FOV: 45 degrees
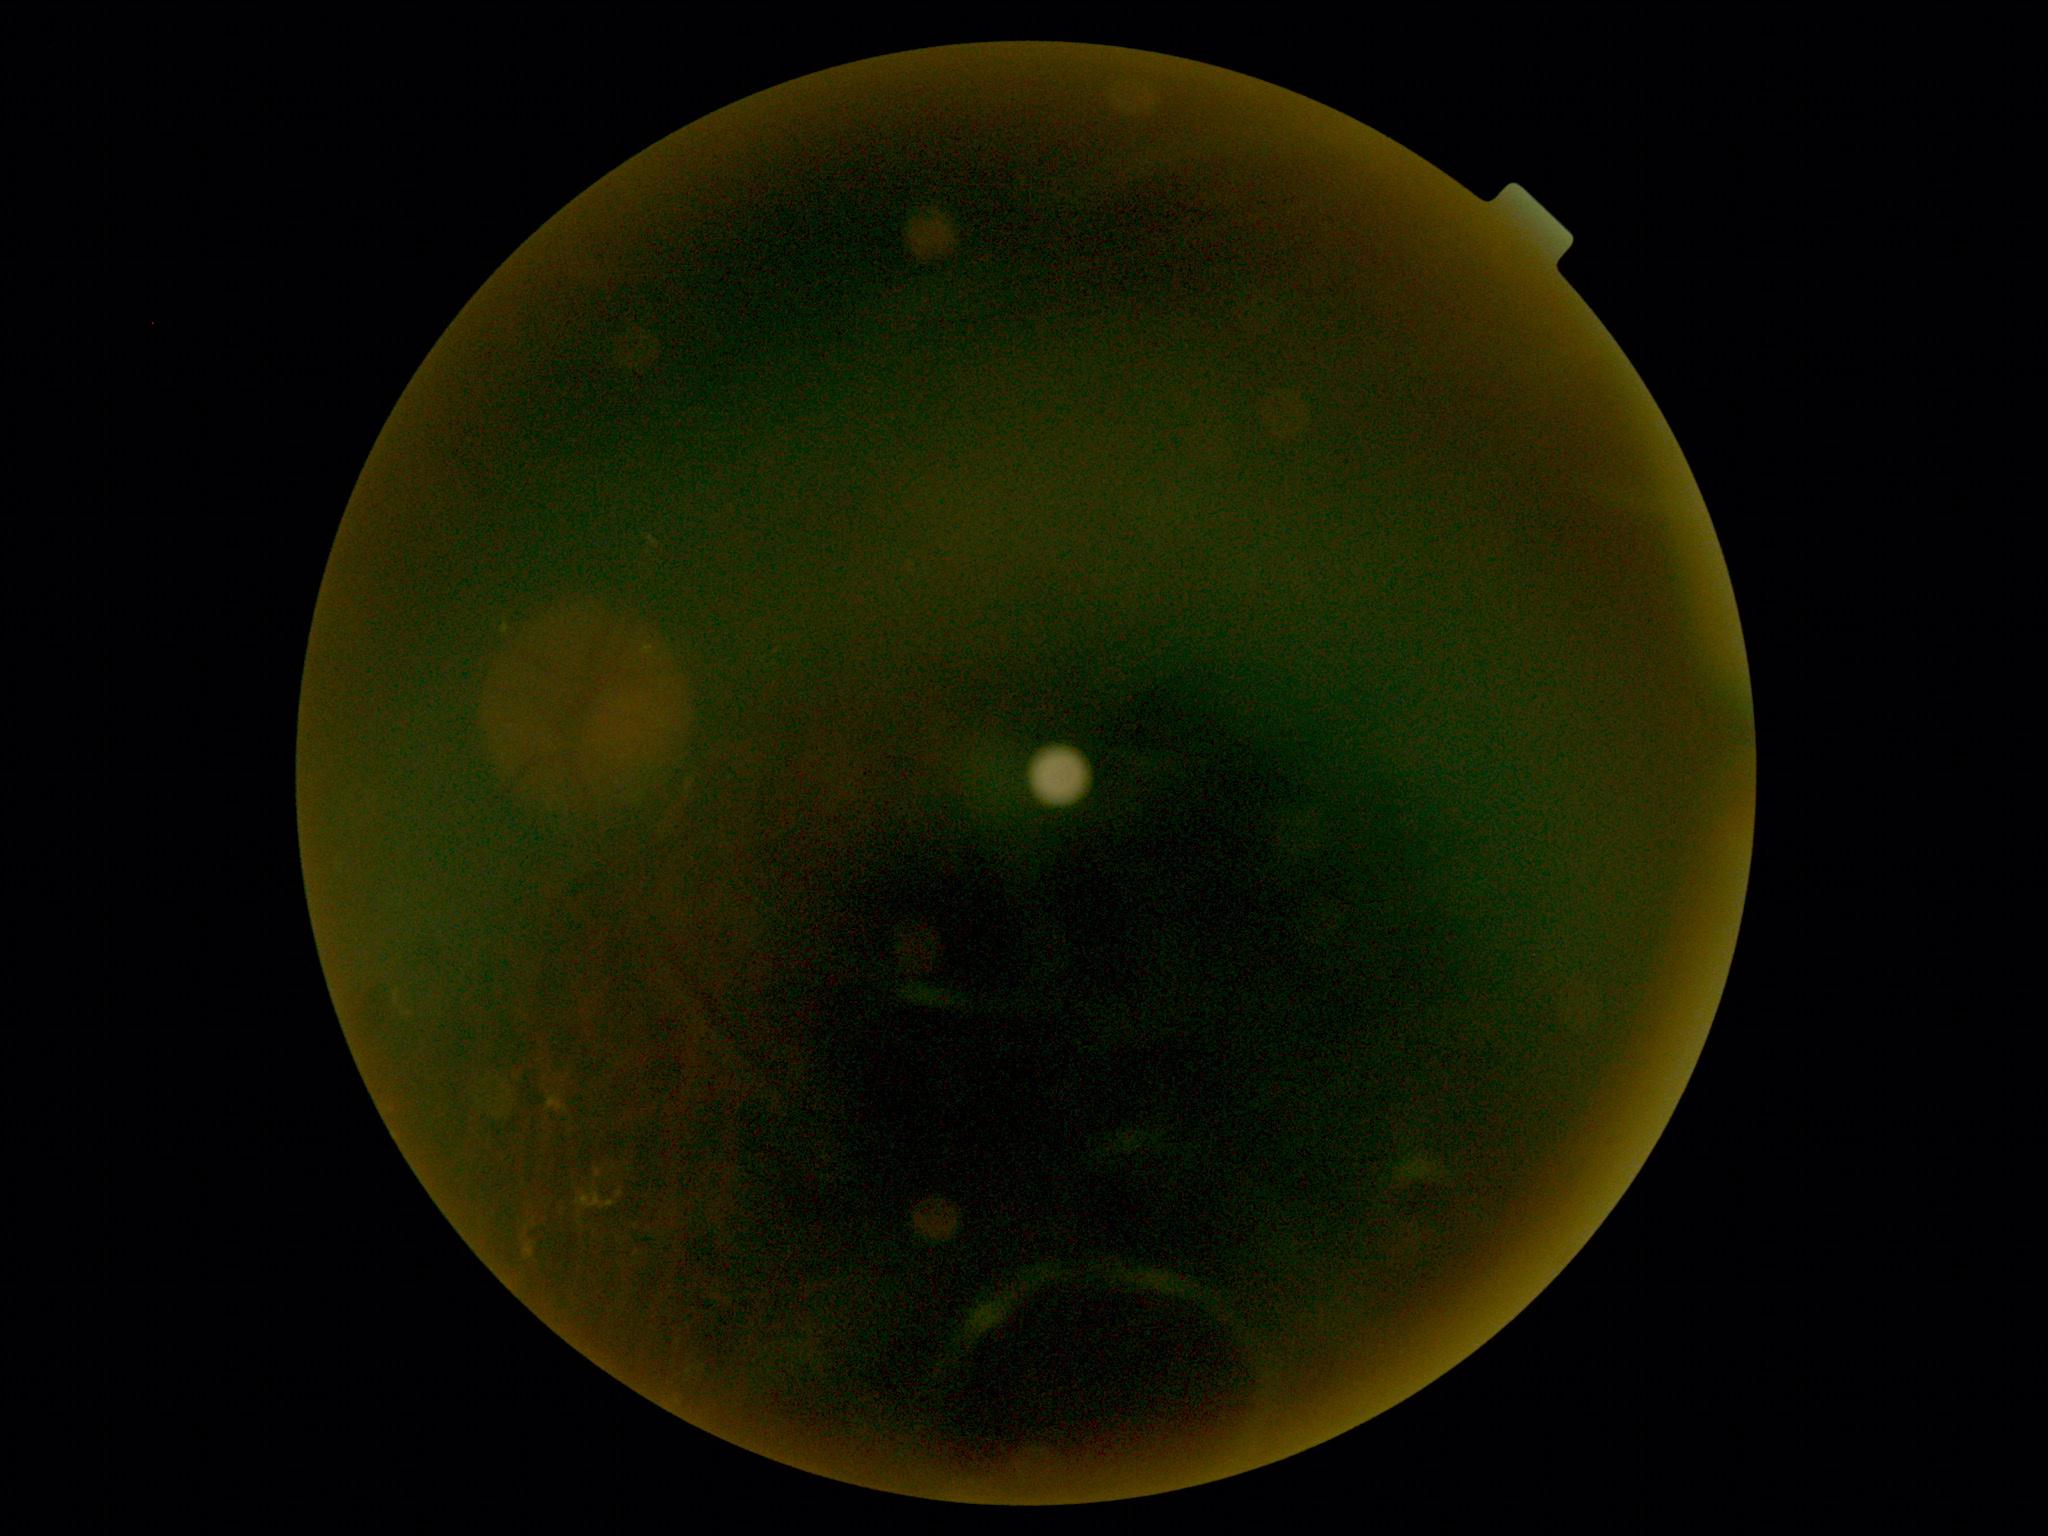
Image quality is insufficient for diabetic retinopathy assessment. Diabetic retinopathy (DR): ungradable due to poor image quality.